Captured with the Phoenix ICON (100° field of view). Wide-field fundus photograph of an infant. 1240 x 1240 pixels — 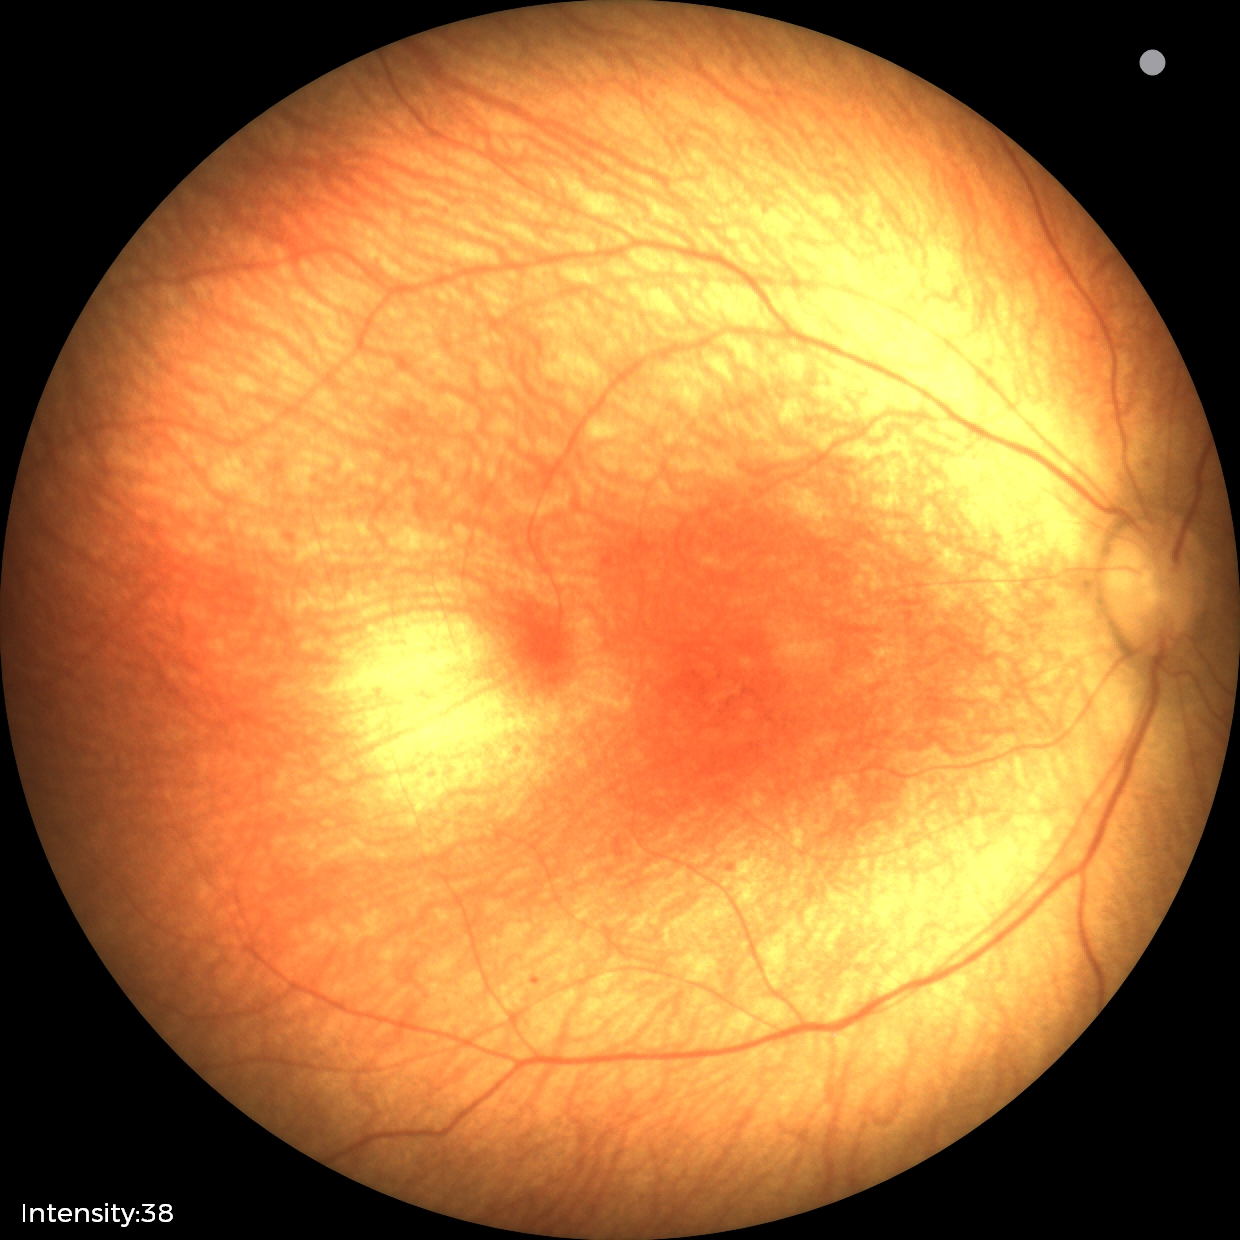 Q: What is the screening diagnosis?
A: normal retinal appearance